Graded on the modified Davis scale.
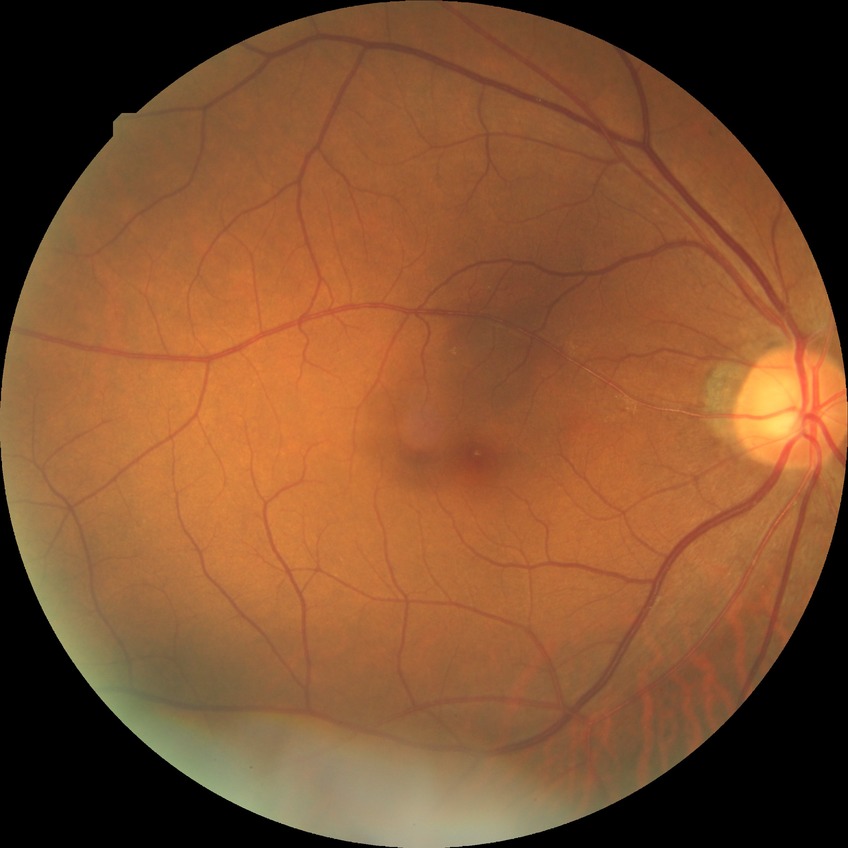 dr_impression: no DR findings
davis_grade: NDR